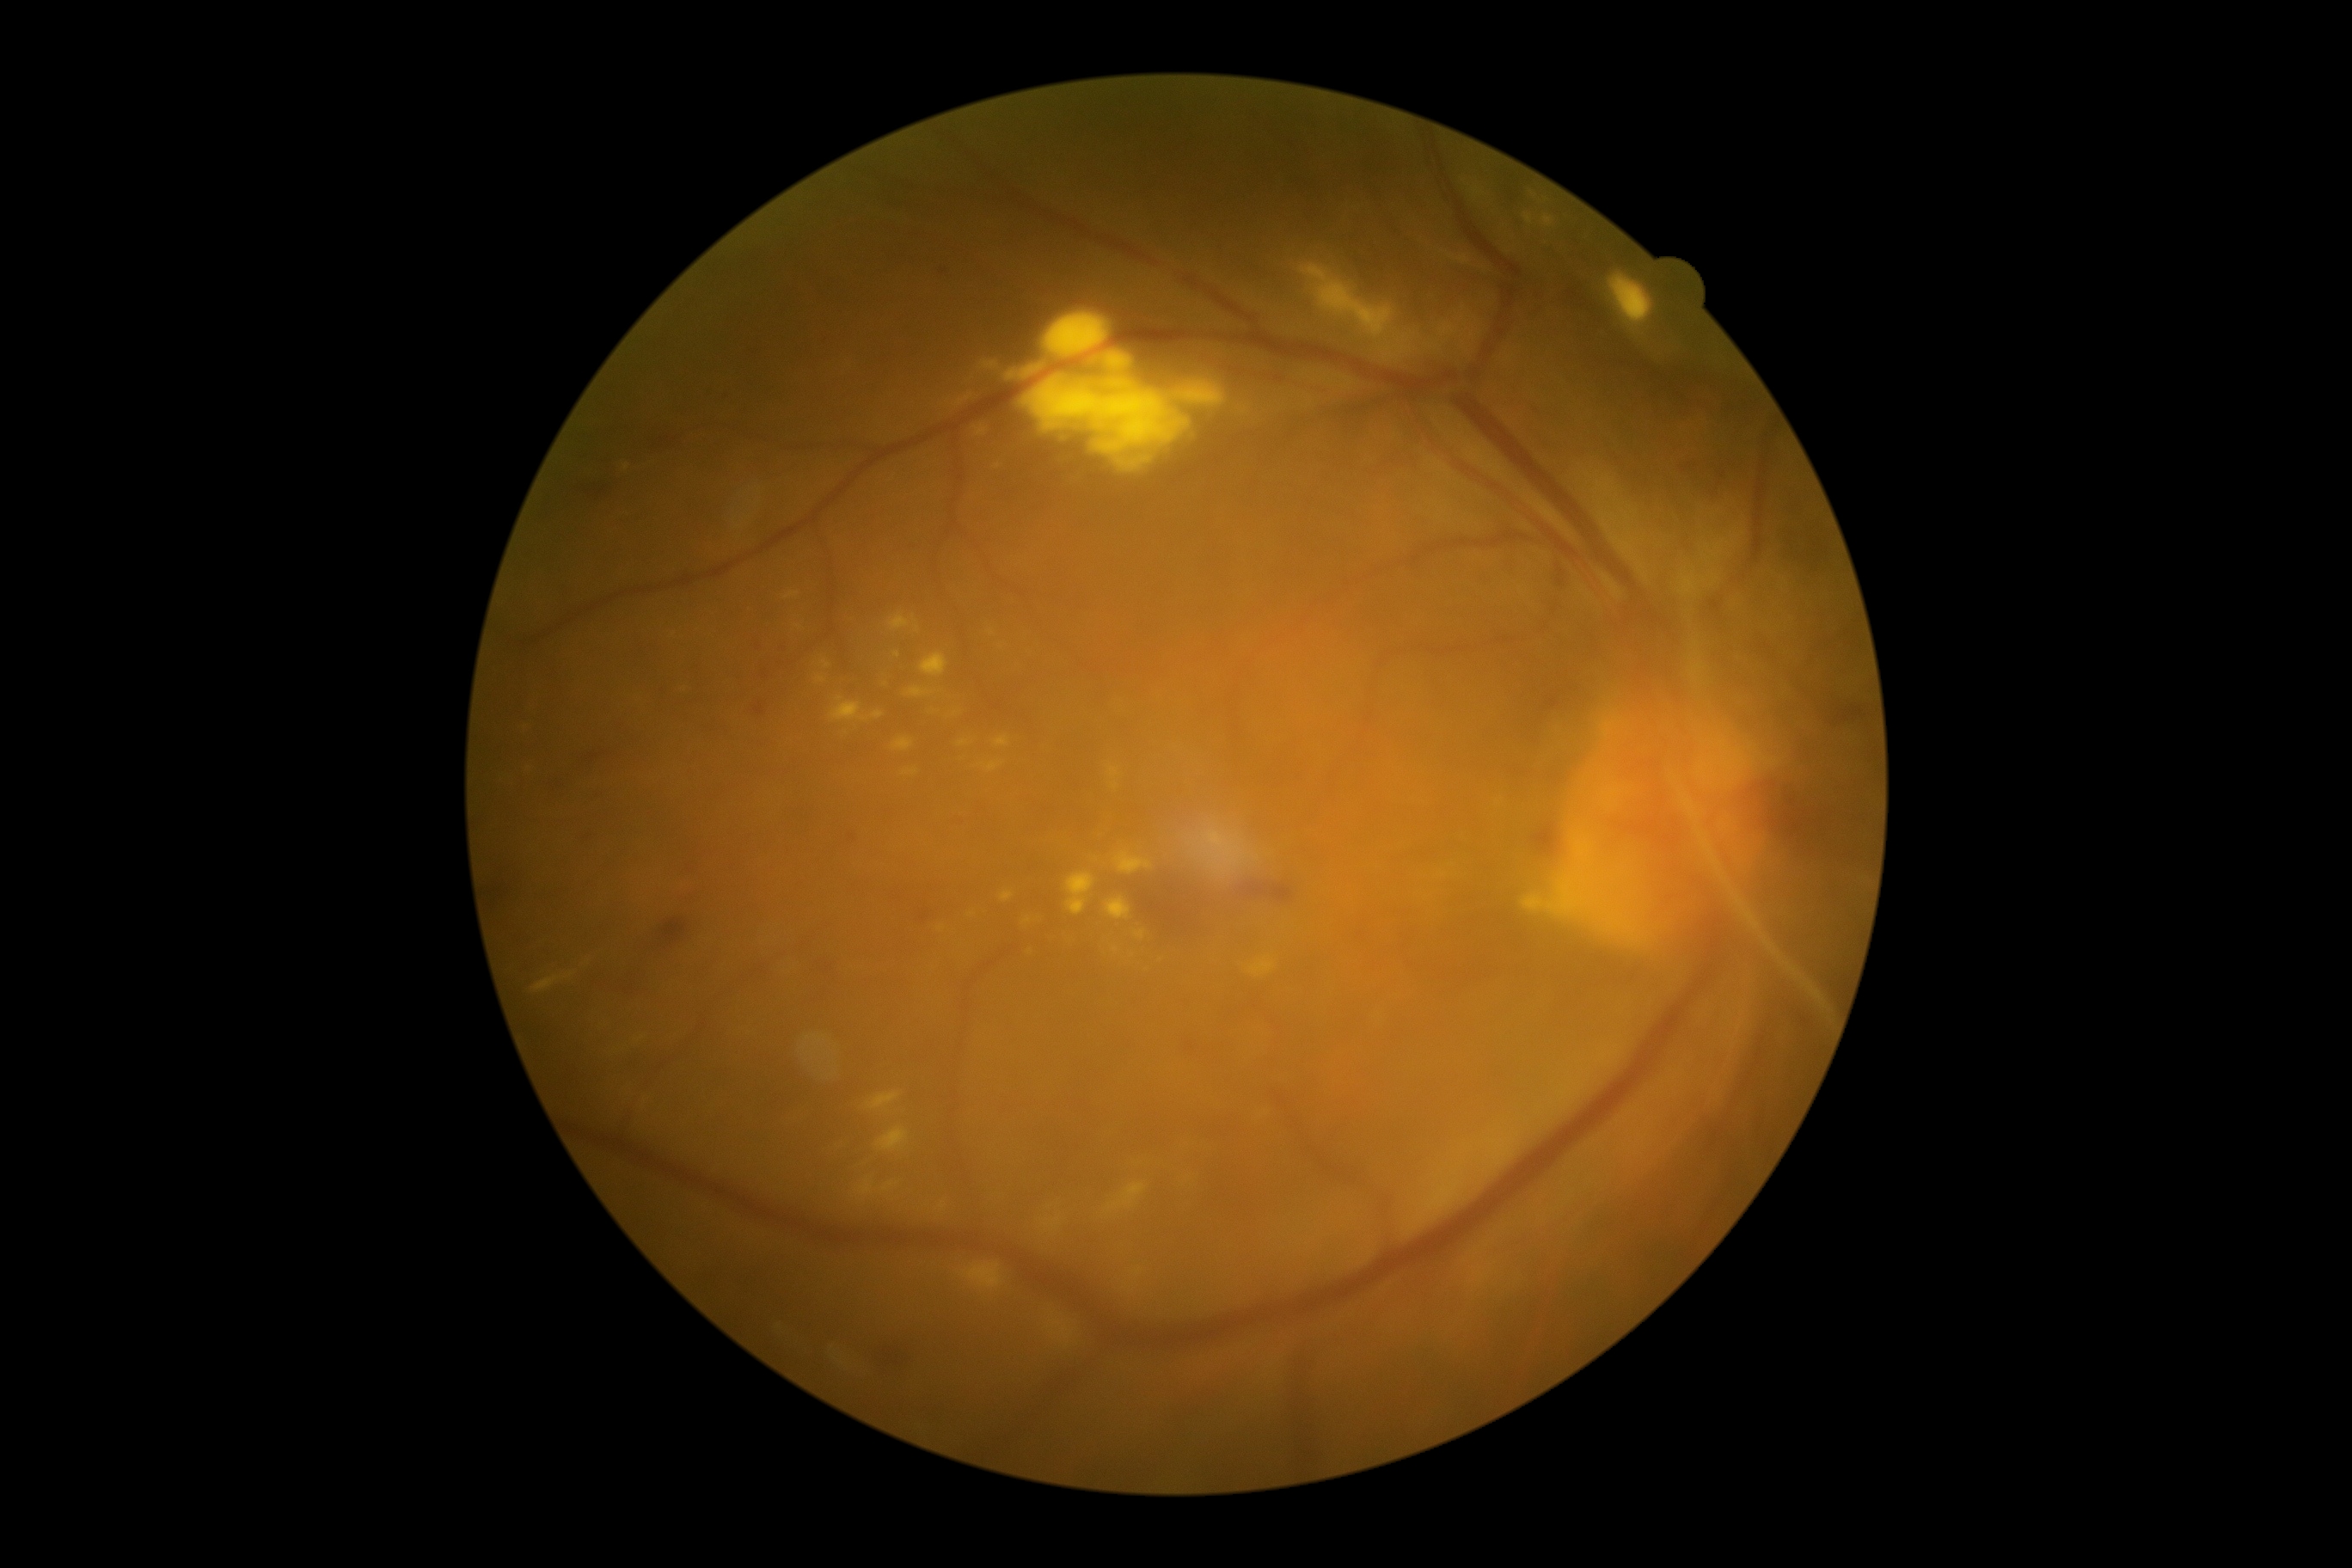 Diabetic retinopathy is proliferative diabetic retinopathy (grade 4) — neovascularization and/or vitreous/pre-retinal hemorrhage
Lesions identified (partial list):
hard exudates (continued) = [x1=891, y1=738, x2=914, y2=752], [x1=1247, y1=957, x2=1277, y2=979], [x1=1522, y1=895, x2=1547, y2=914], [x1=903, y1=769, x2=919, y2=776], [x1=1044, y1=314, x2=1110, y2=358], [x1=1001, y1=891, x2=1015, y2=903], [x1=1070, y1=426, x2=1087, y2=431], [x1=1115, y1=852, x2=1153, y2=876], [x1=816, y1=677, x2=826, y2=683], [x1=1132, y1=1270, x2=1144, y2=1278], [x1=1449, y1=255, x2=1471, y2=266], [x1=527, y1=726, x2=536, y2=733], [x1=1110, y1=766, x2=1120, y2=780], [x1=1067, y1=873, x2=1094, y2=916]
Small hard exudates near point(1115, 786), point(799, 627), point(917, 629), point(1115, 950)